Nonmydriatic:
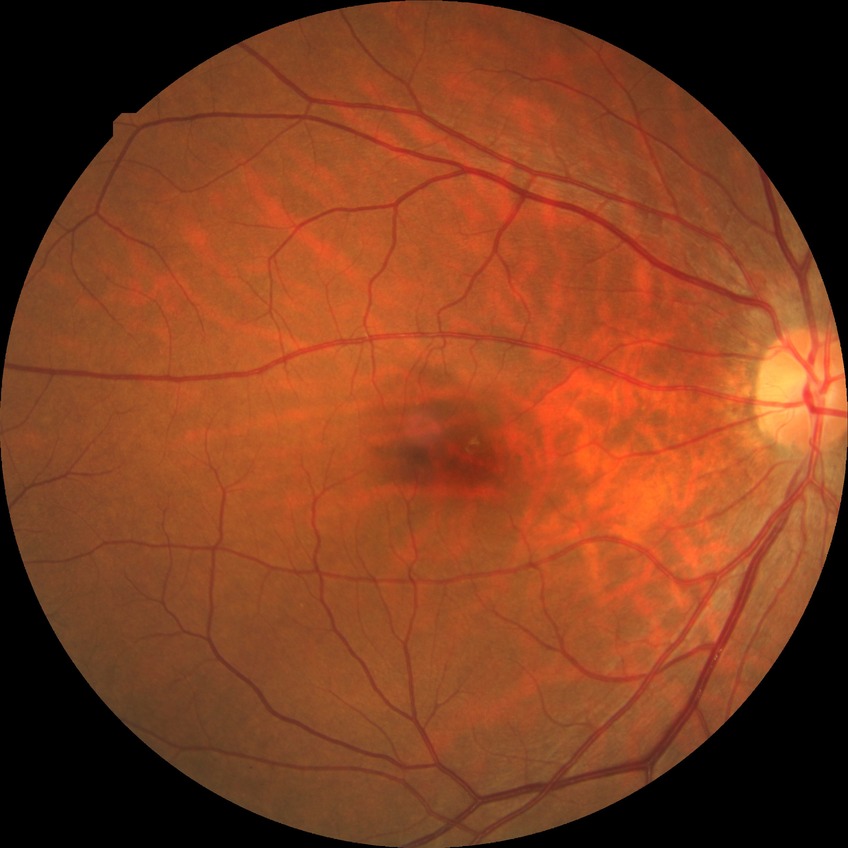
diabetic retinopathy (DR) = no diabetic retinopathy (NDR).